Without pupil dilation:
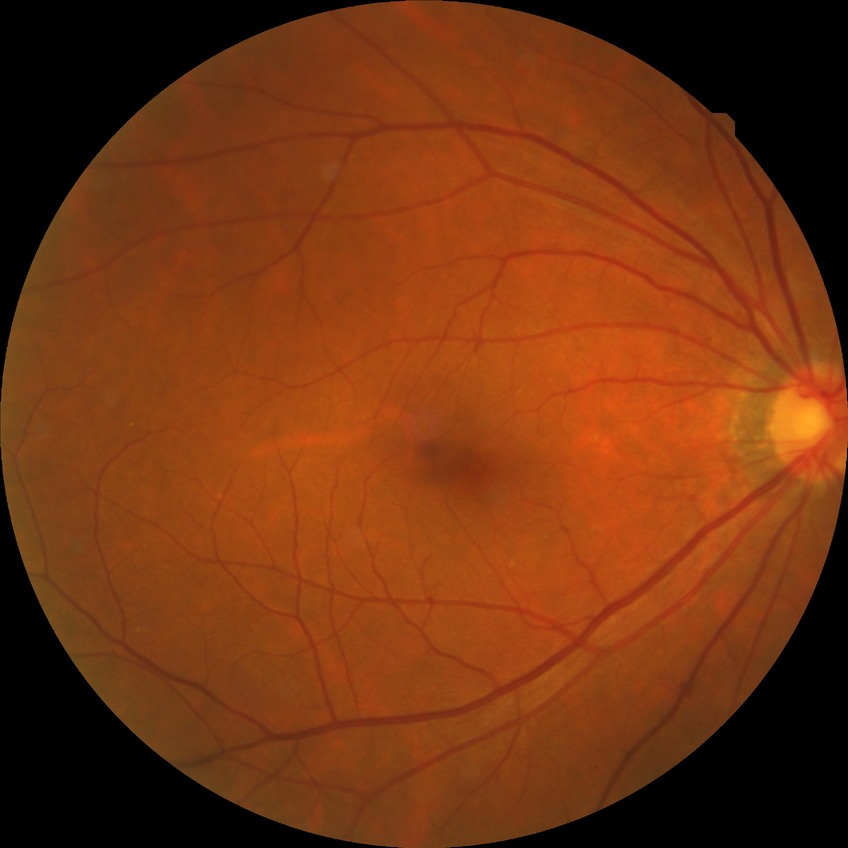

Assessment:
* diabetic retinopathy (DR) — no diabetic retinopathy (NDR)